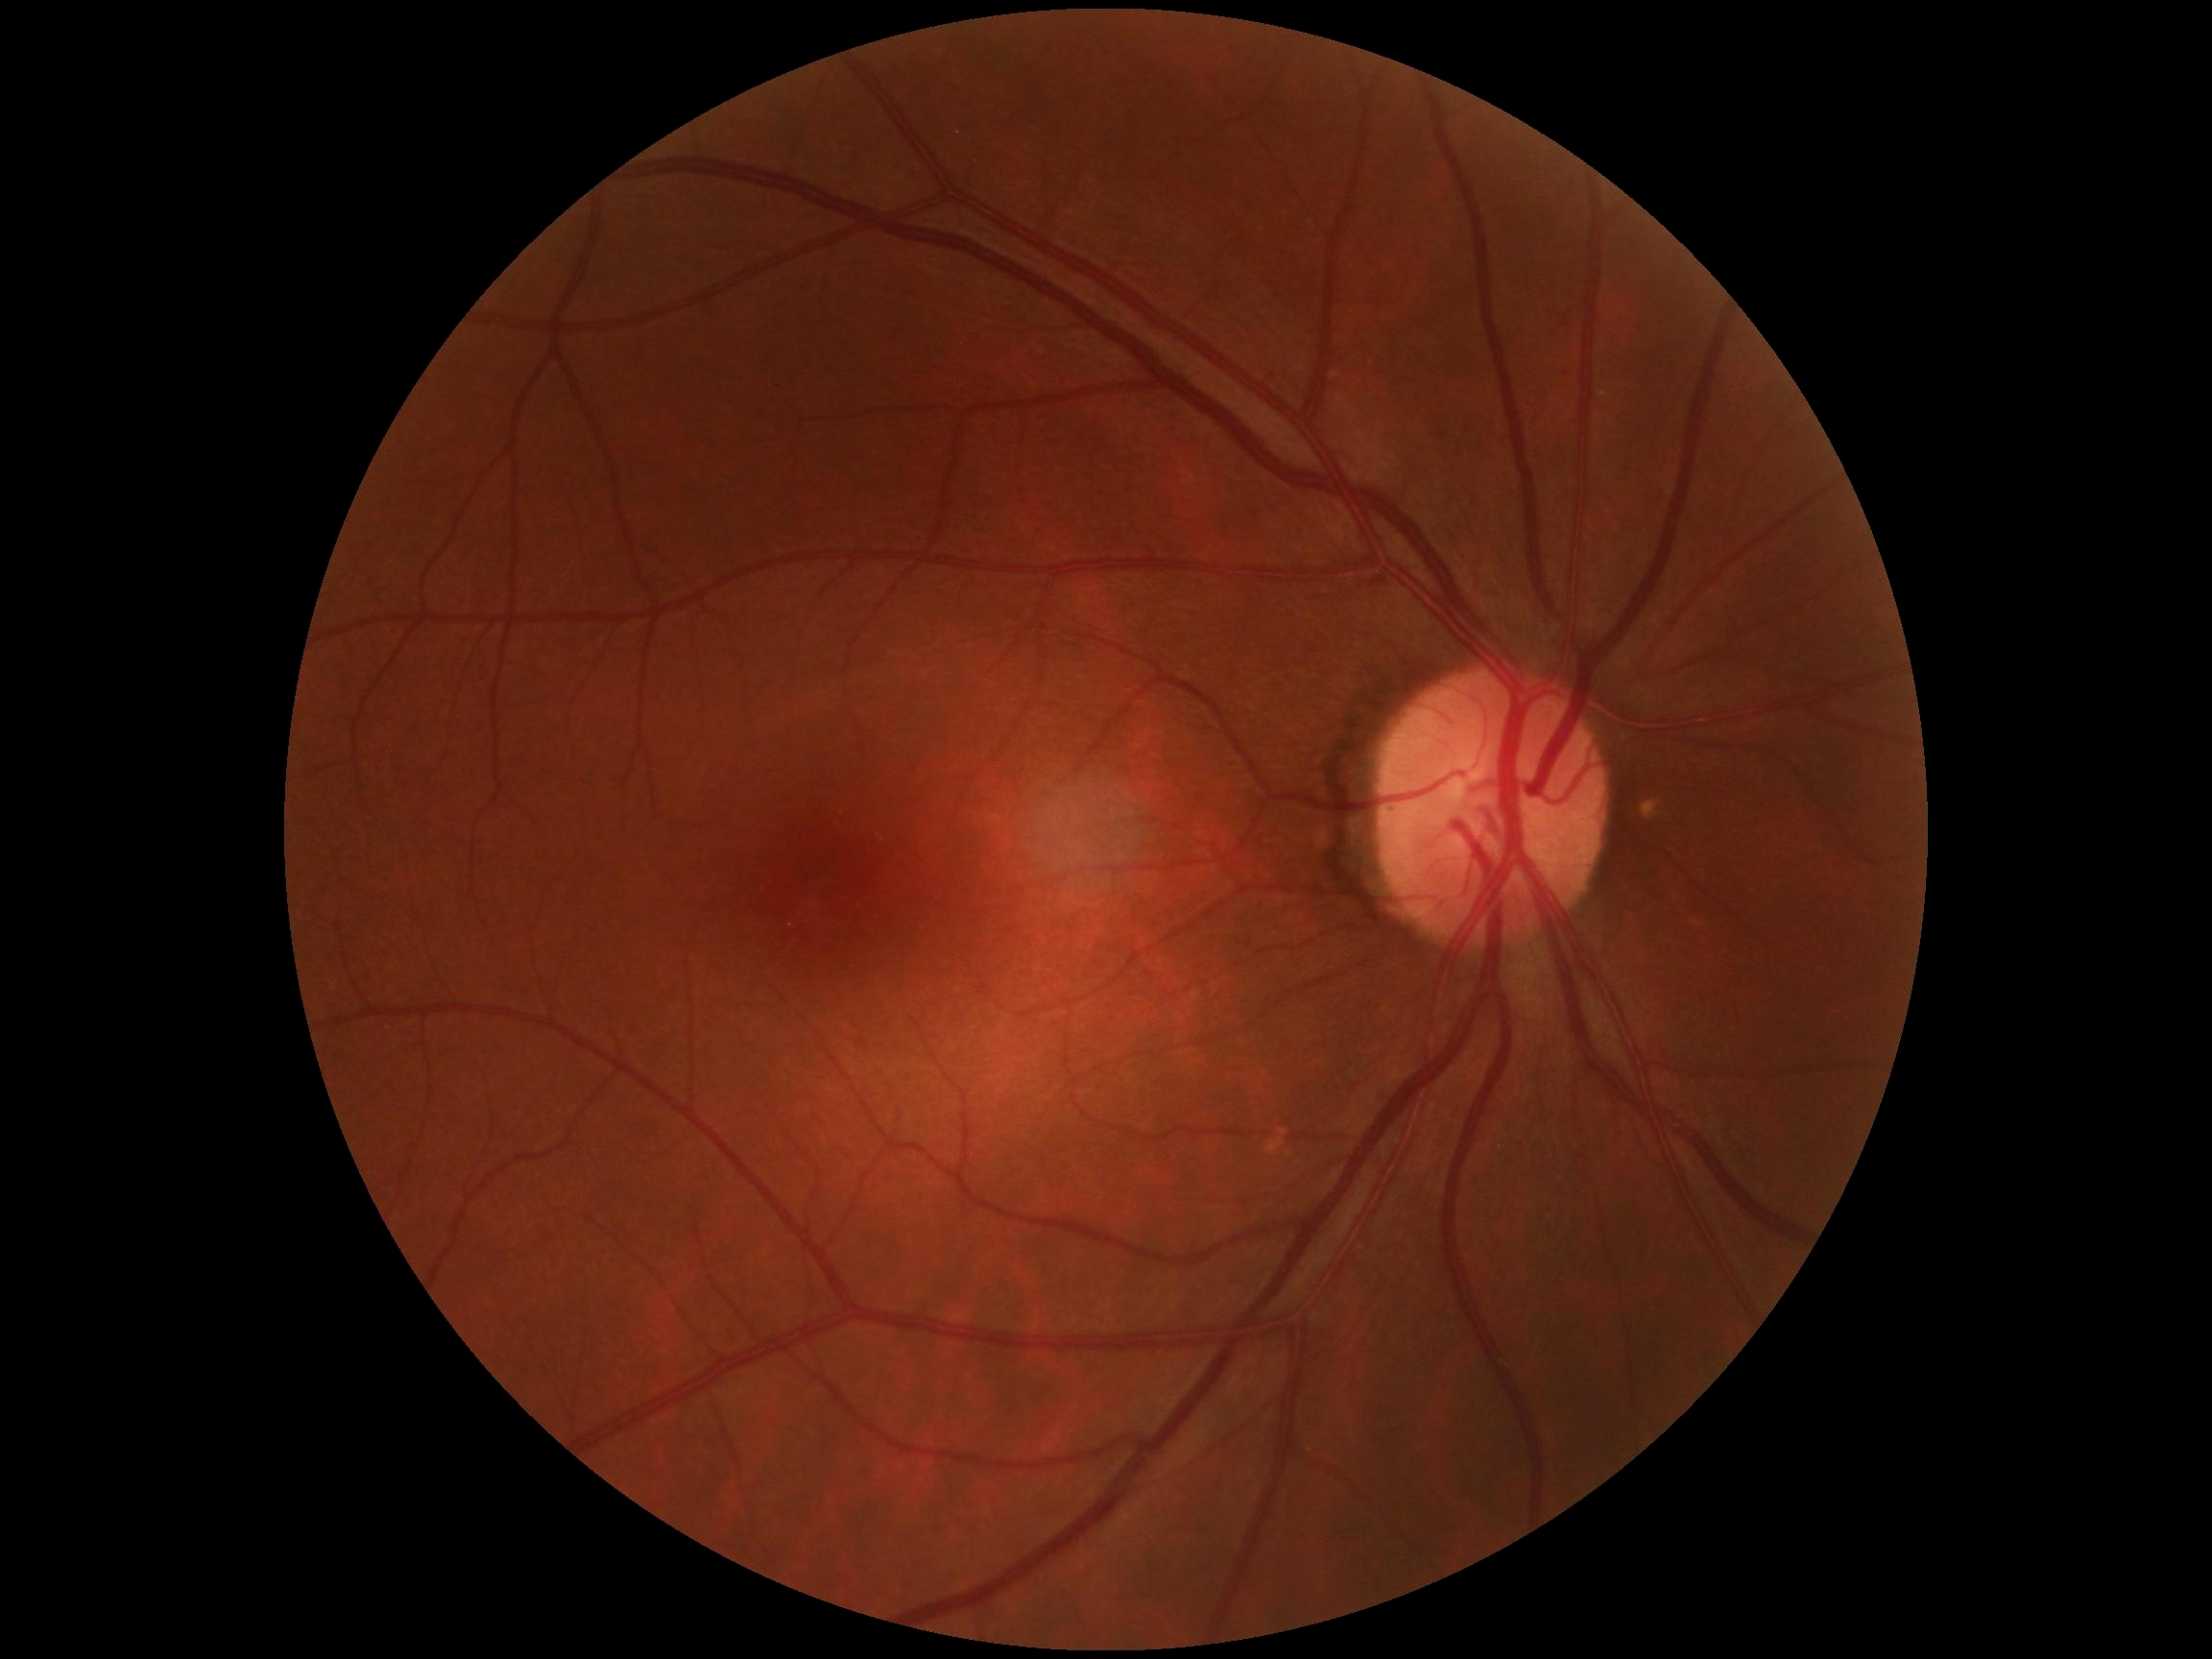 Diabetic retinopathy (DR) is 0.
No DR findings.